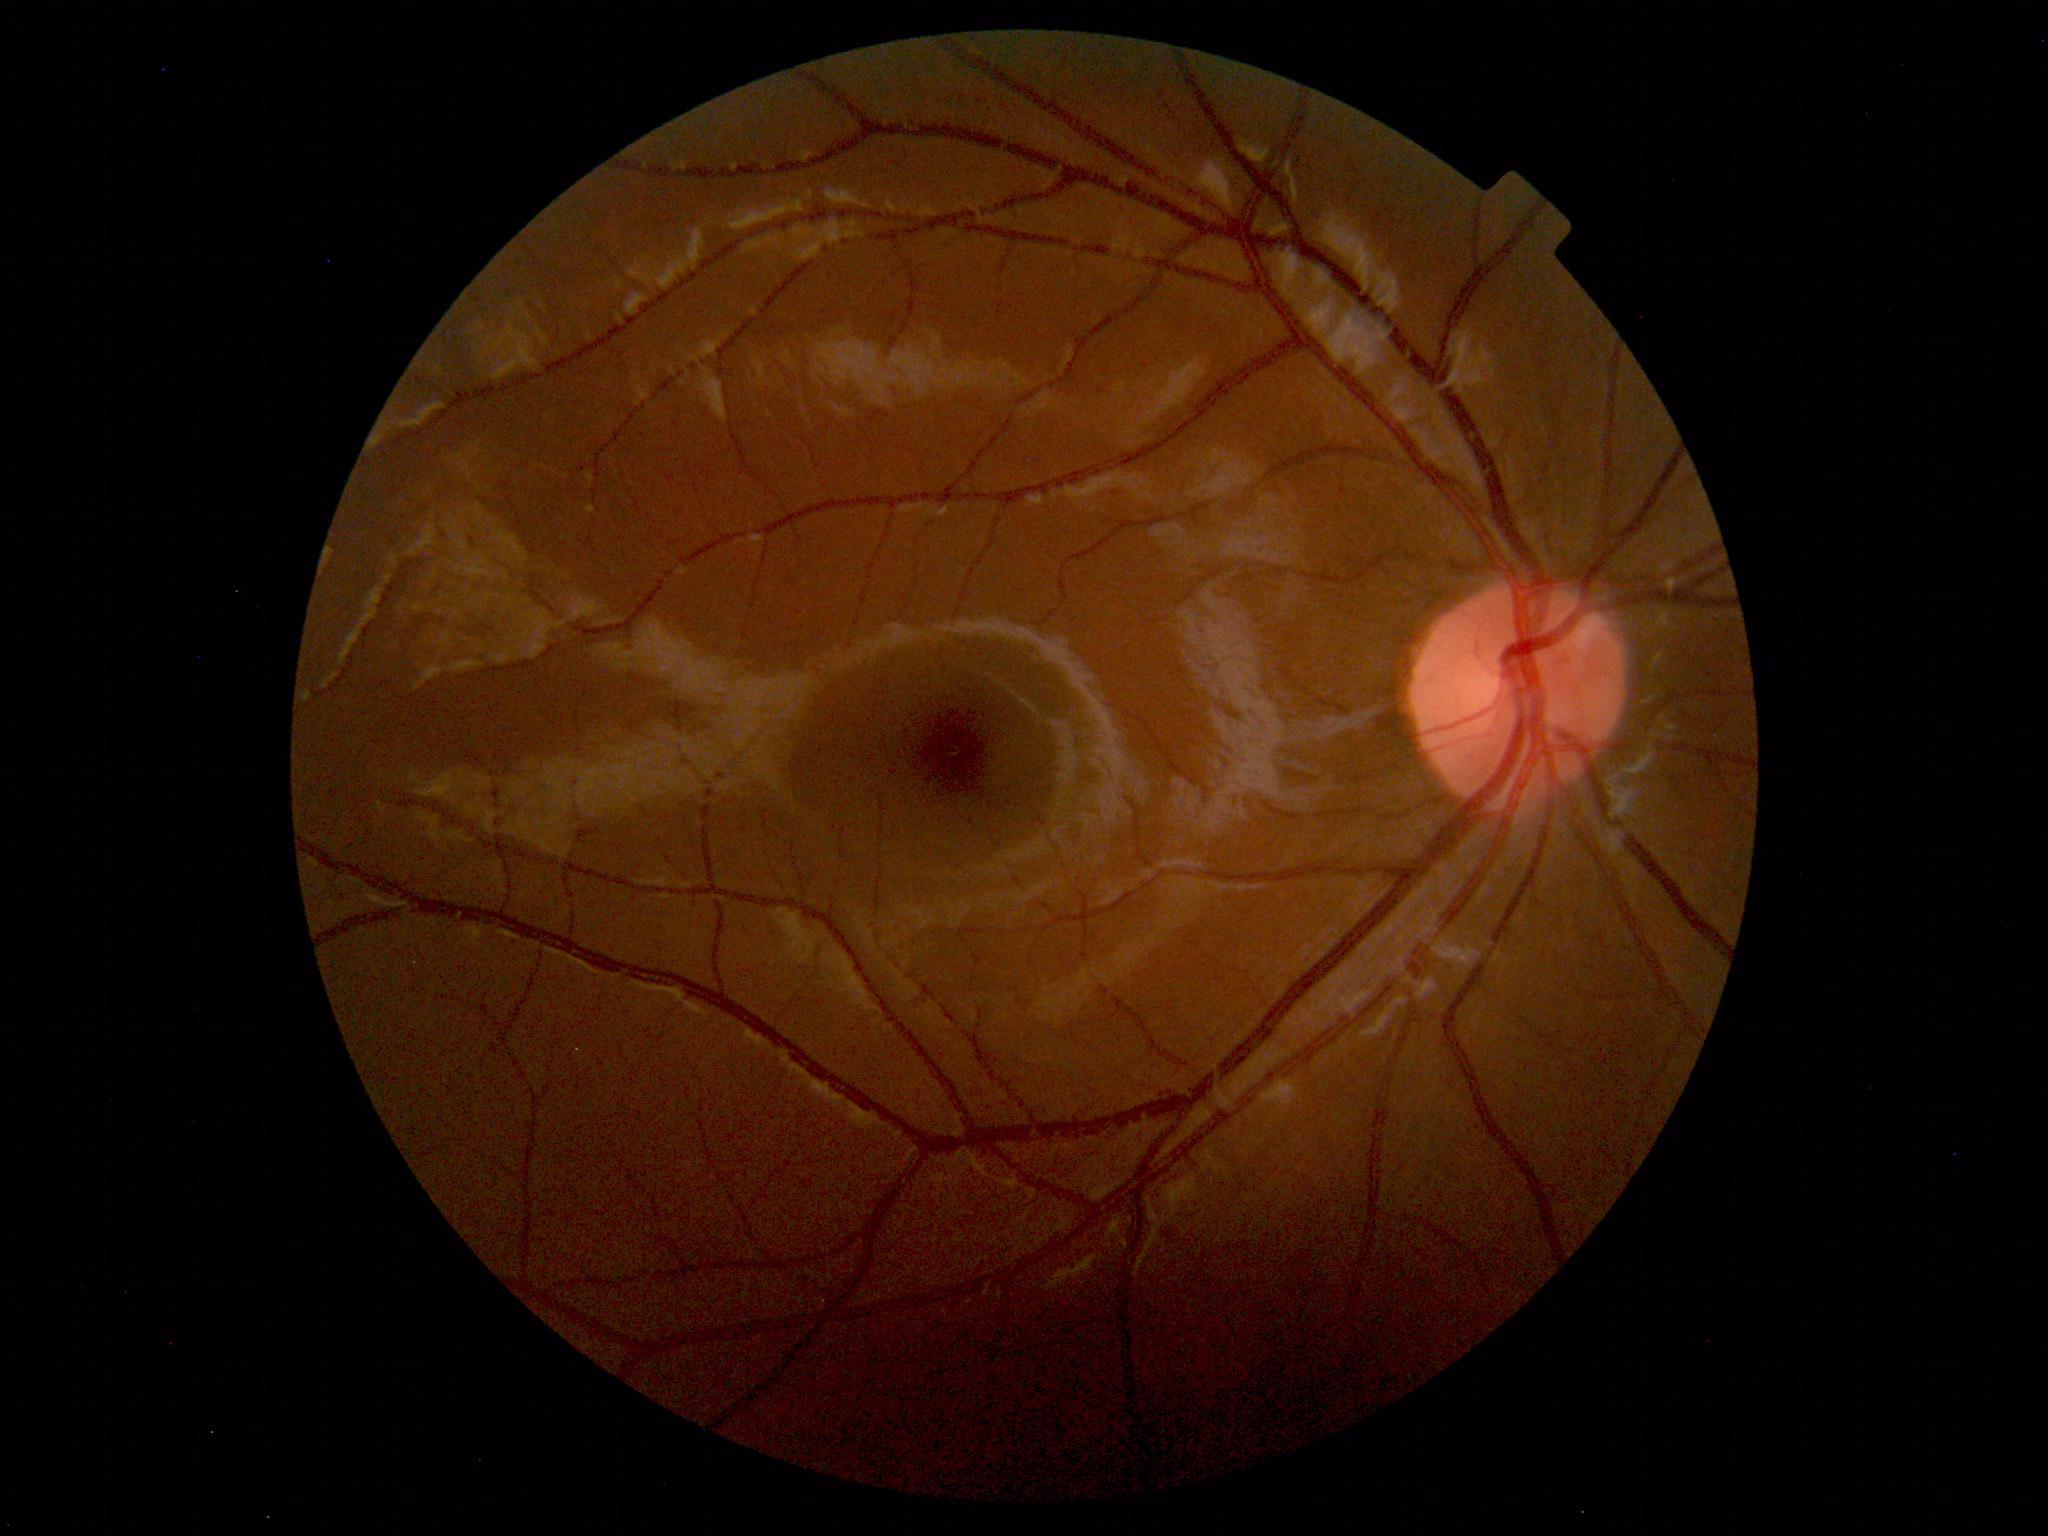 Normal retinal fundus image with no abnormalities identified.